2352x1568, fundus photo, 45-degree field of view
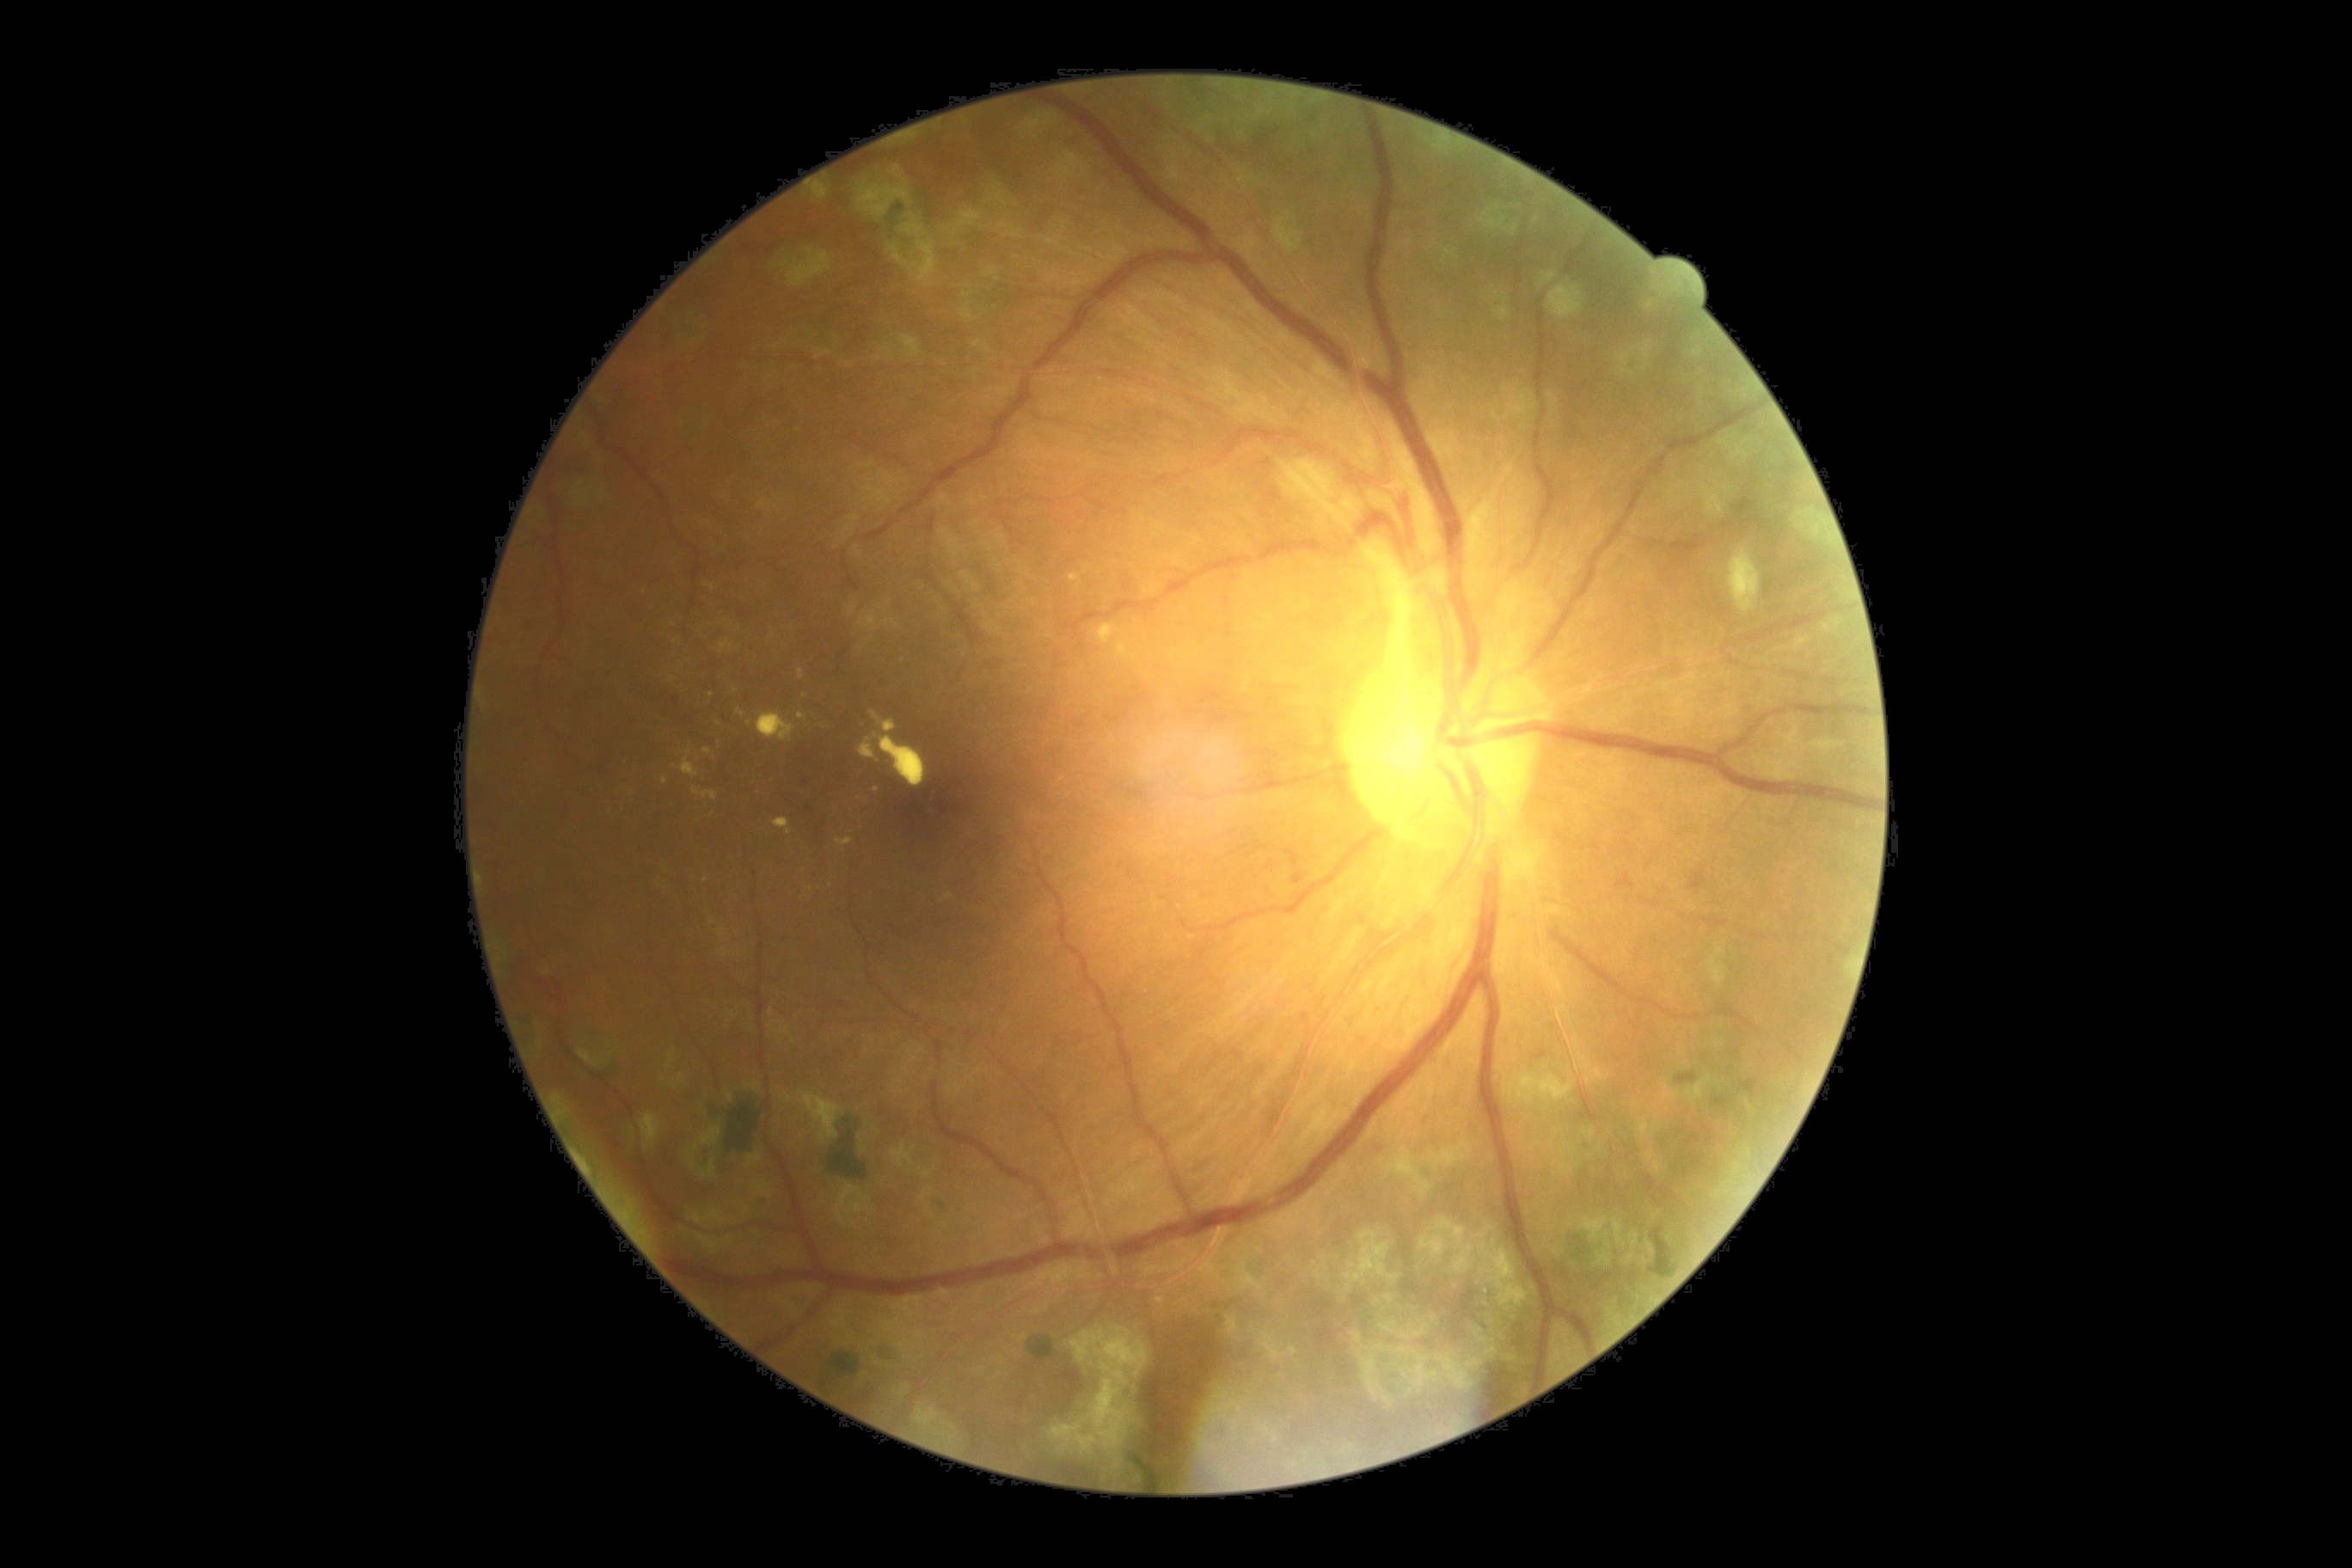

Retinopathy: grade 2 — more than just microaneurysms but less than severe NPDR
Selected lesions:
soft exudates: none
microaneurysms (continued): {"left": 1294, "top": 874, "right": 1306, "bottom": 886}, {"left": 673, "top": 697, "right": 682, "bottom": 706}
Smaller microaneurysms around pt(803, 805), pt(728, 781), pt(805, 783), pt(788, 937)
hemorrhages: {"left": 1617, "top": 874, "right": 1634, "bottom": 890}
hard exudates (continued): {"left": 706, "top": 584, "right": 714, "bottom": 591}, {"left": 835, "top": 838, "right": 852, "bottom": 852}, {"left": 661, "top": 776, "right": 668, "bottom": 787}, {"left": 737, "top": 709, "right": 745, "bottom": 718}, {"left": 773, "top": 818, "right": 792, "bottom": 836}, {"left": 692, "top": 787, "right": 718, "bottom": 800}, {"left": 682, "top": 750, "right": 699, "bottom": 778}, {"left": 859, "top": 711, "right": 926, "bottom": 788}, {"left": 756, "top": 713, "right": 795, "bottom": 742}, {"left": 799, "top": 713, "right": 807, "bottom": 720}, {"left": 799, "top": 668, "right": 805, "bottom": 682}
Smaller hard exudates around pt(720, 724), pt(672, 679), pt(824, 726), pt(711, 695), pt(876, 790), pt(707, 752), pt(675, 625), pt(736, 692), pt(750, 723)